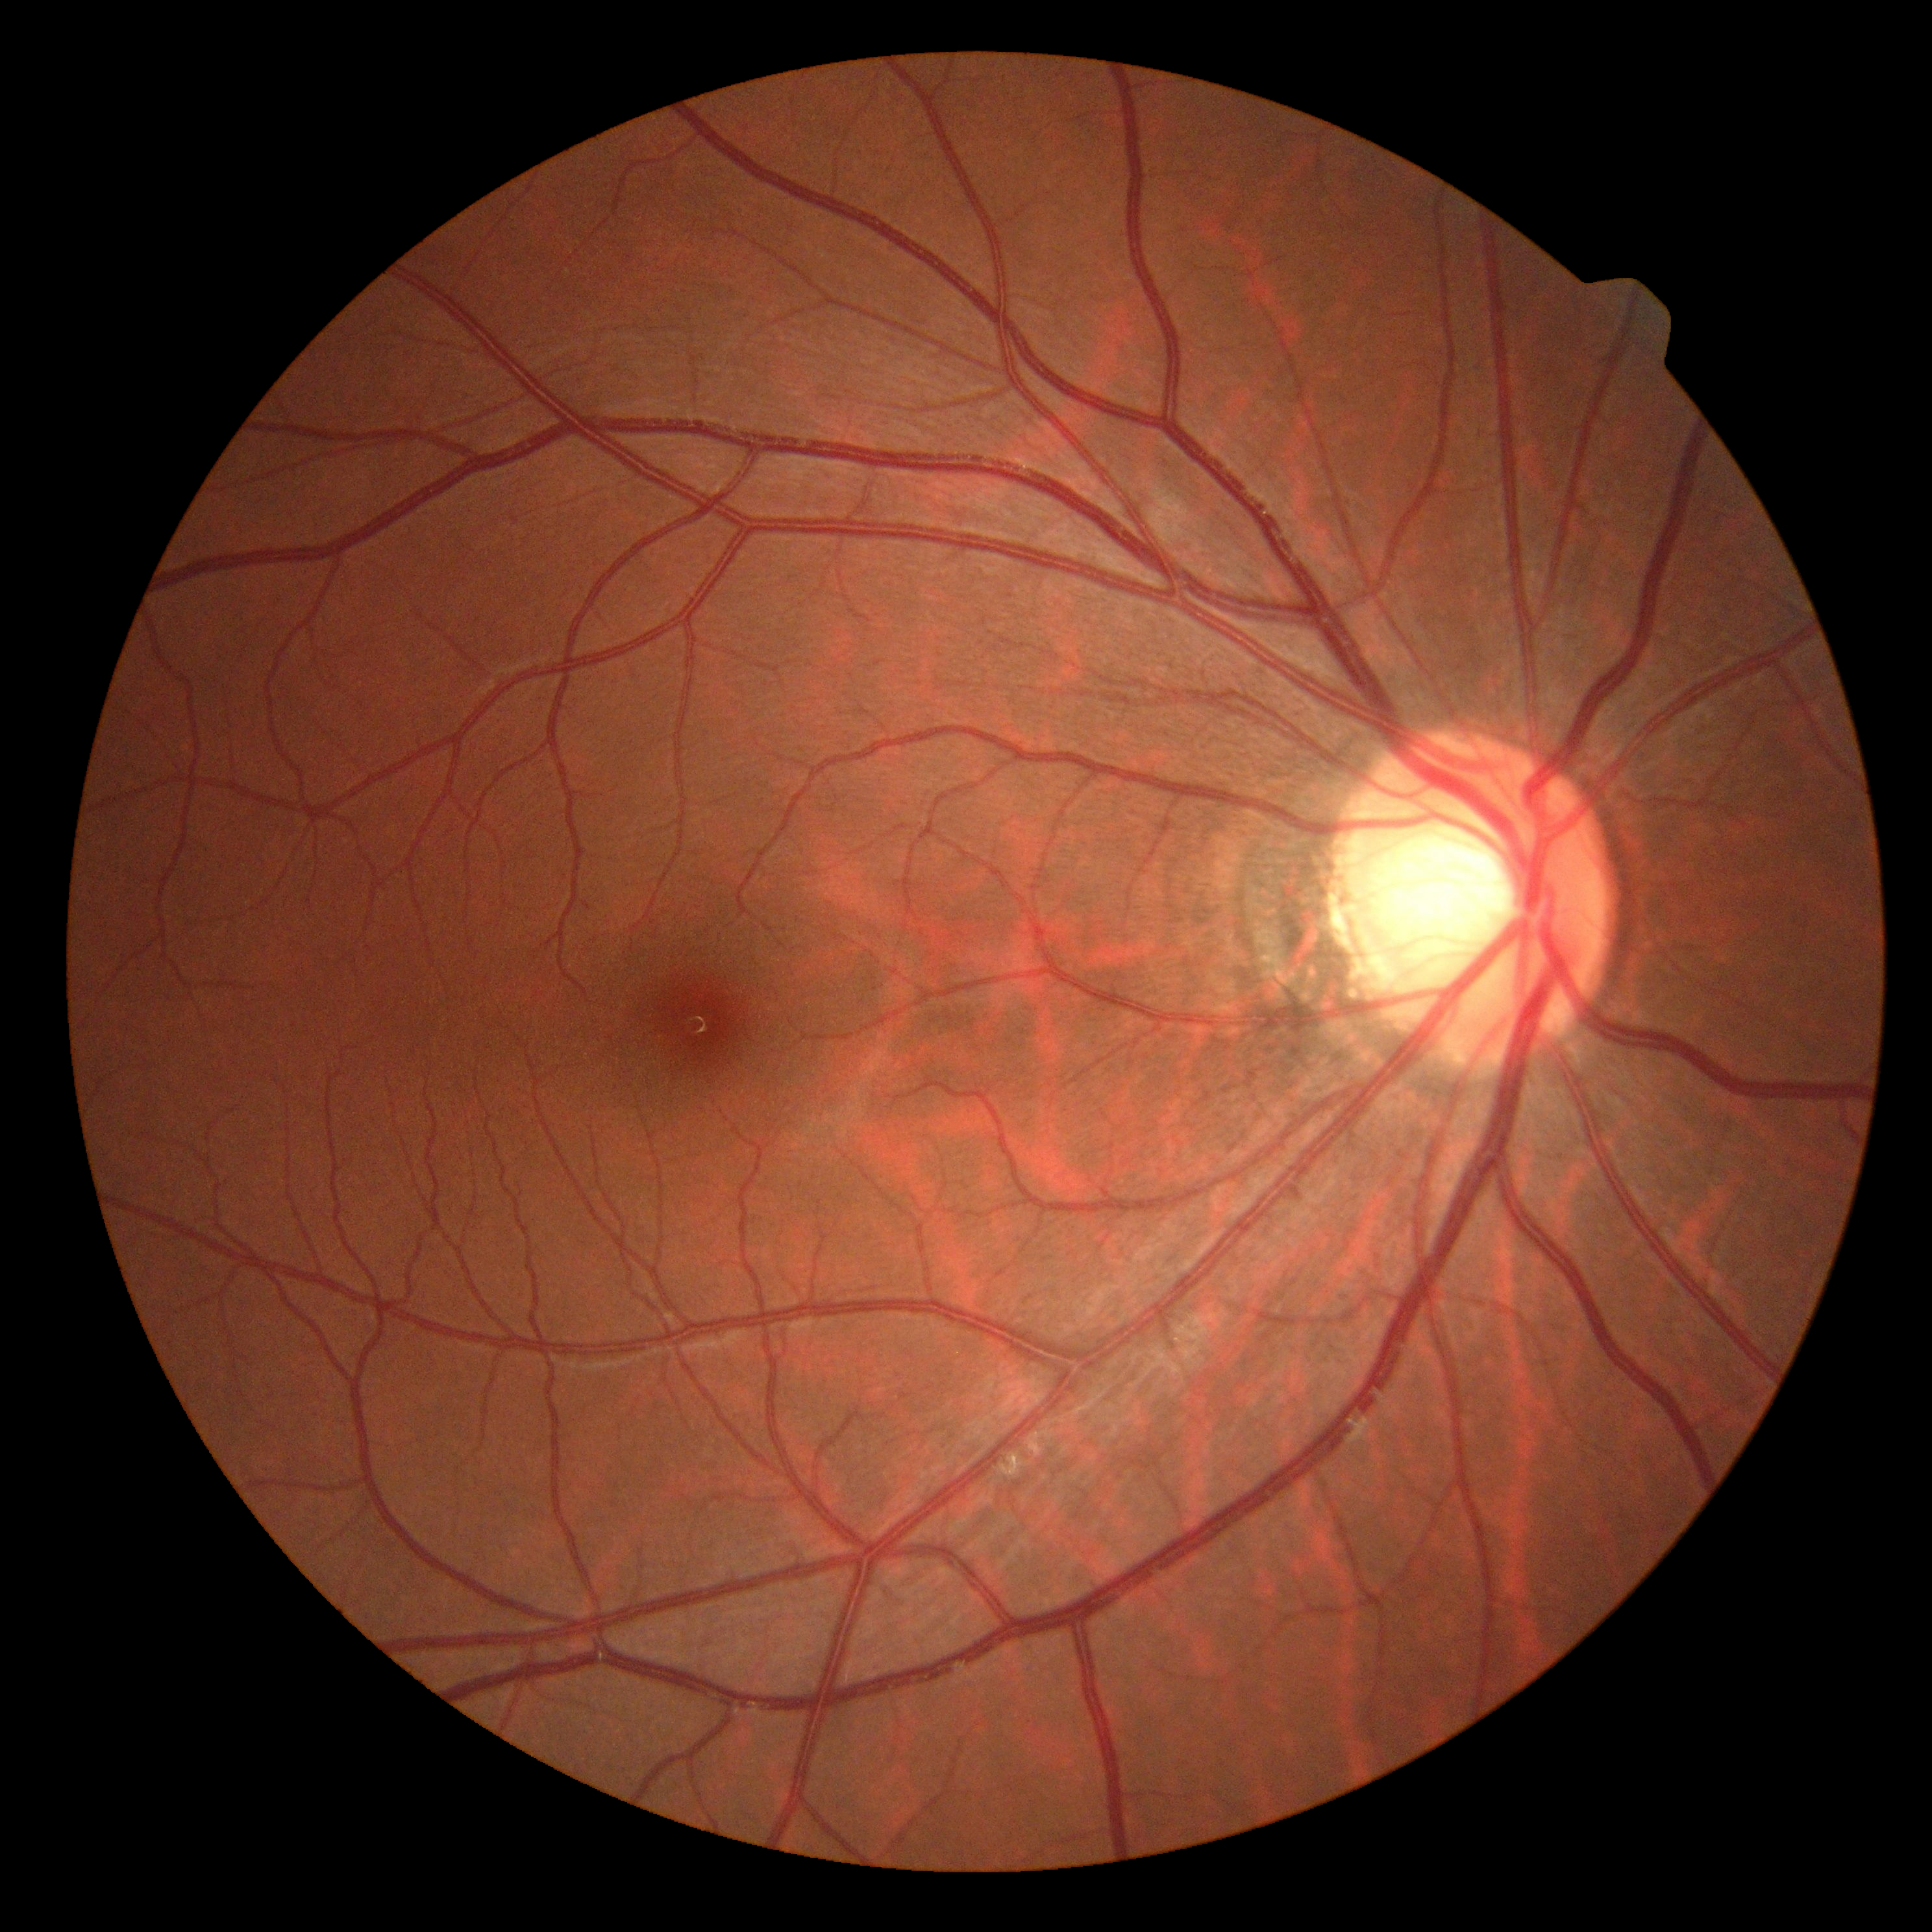 Diabetic retinopathy (DR): no apparent retinopathy (grade 0).